Modified Davis grading.
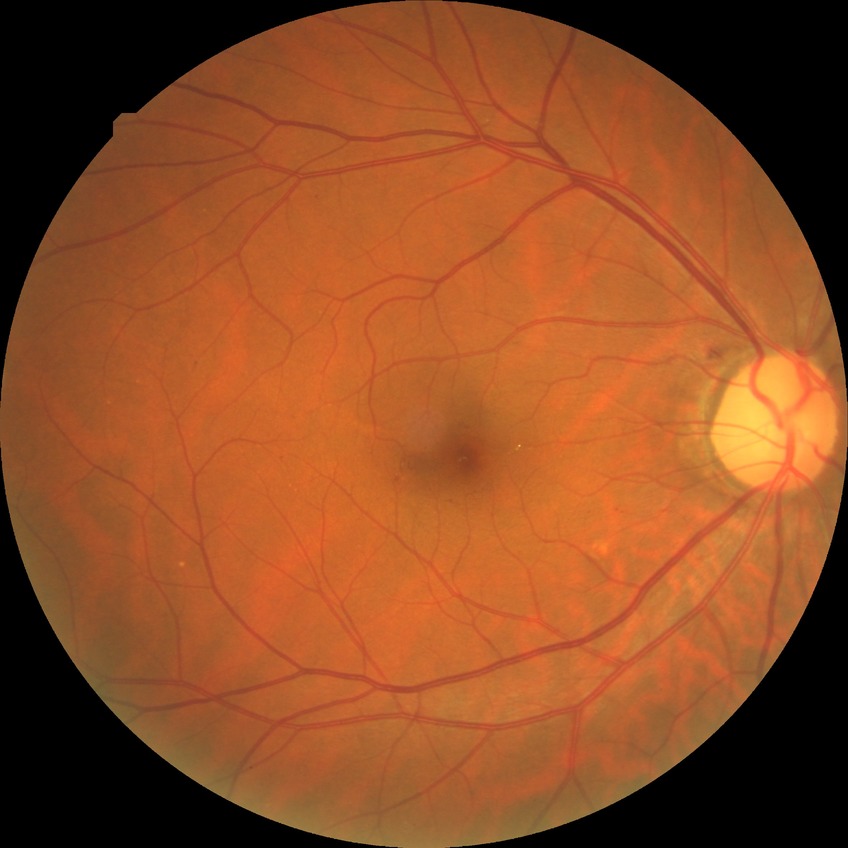

diabetic retinopathy stage: simple diabetic retinopathy.